UWF retinal mosaic — 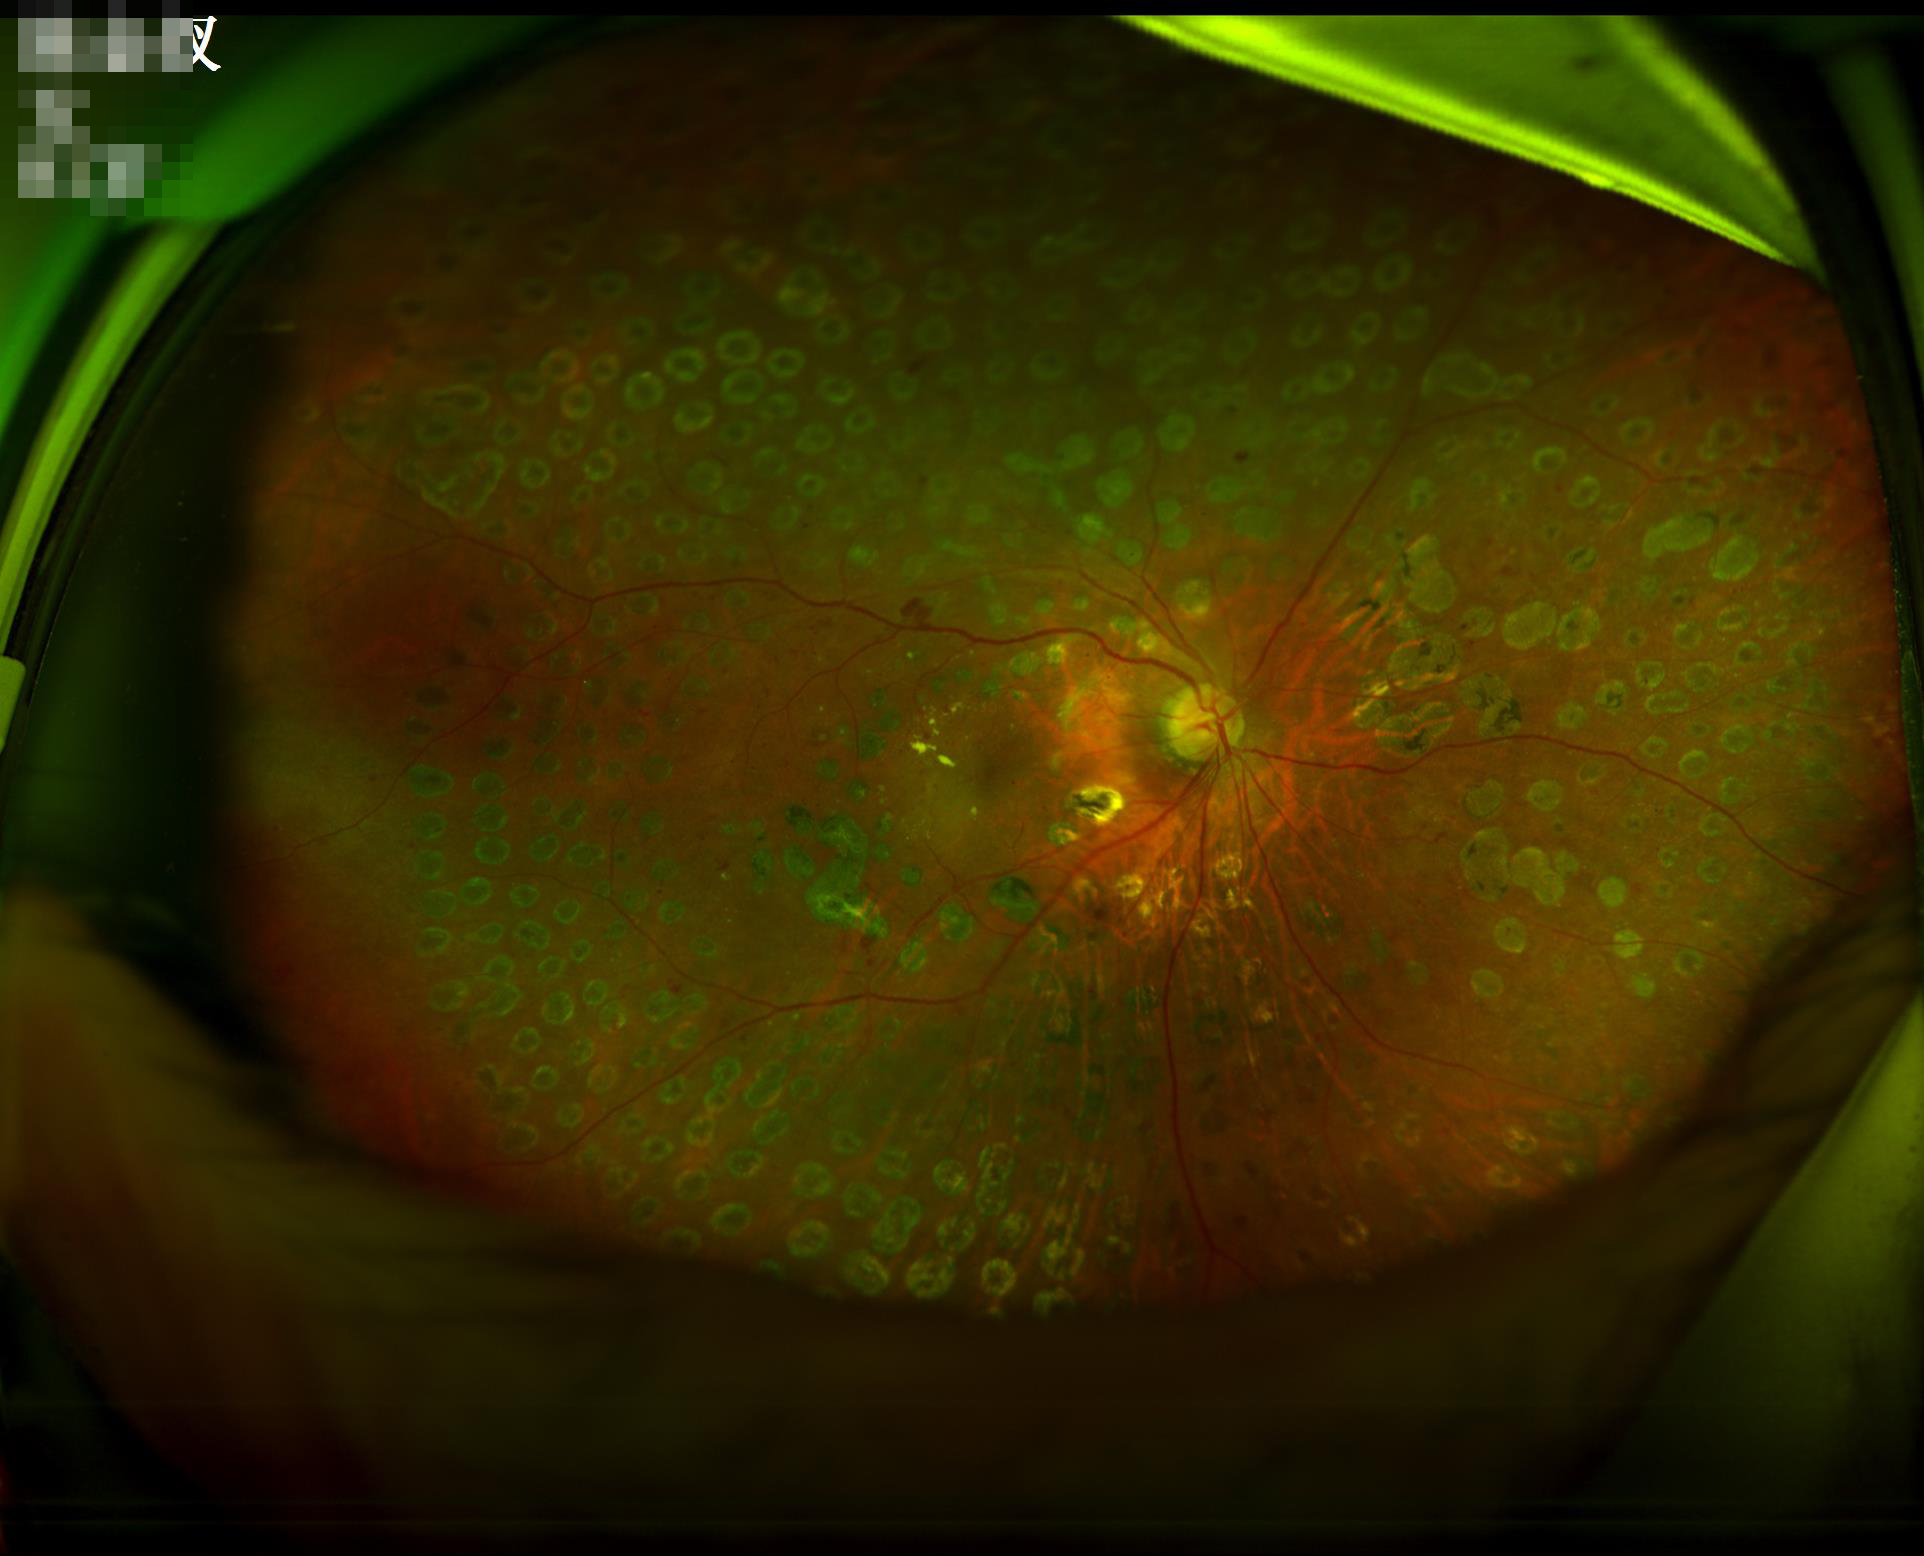

Image is sharp throughout the field.
No over- or under-exposure.
Overall quality is good and the image is gradable.
Adequate contrast for distinguishing structures.